2352x1568px · fundus photo · FOV: 45 degrees: 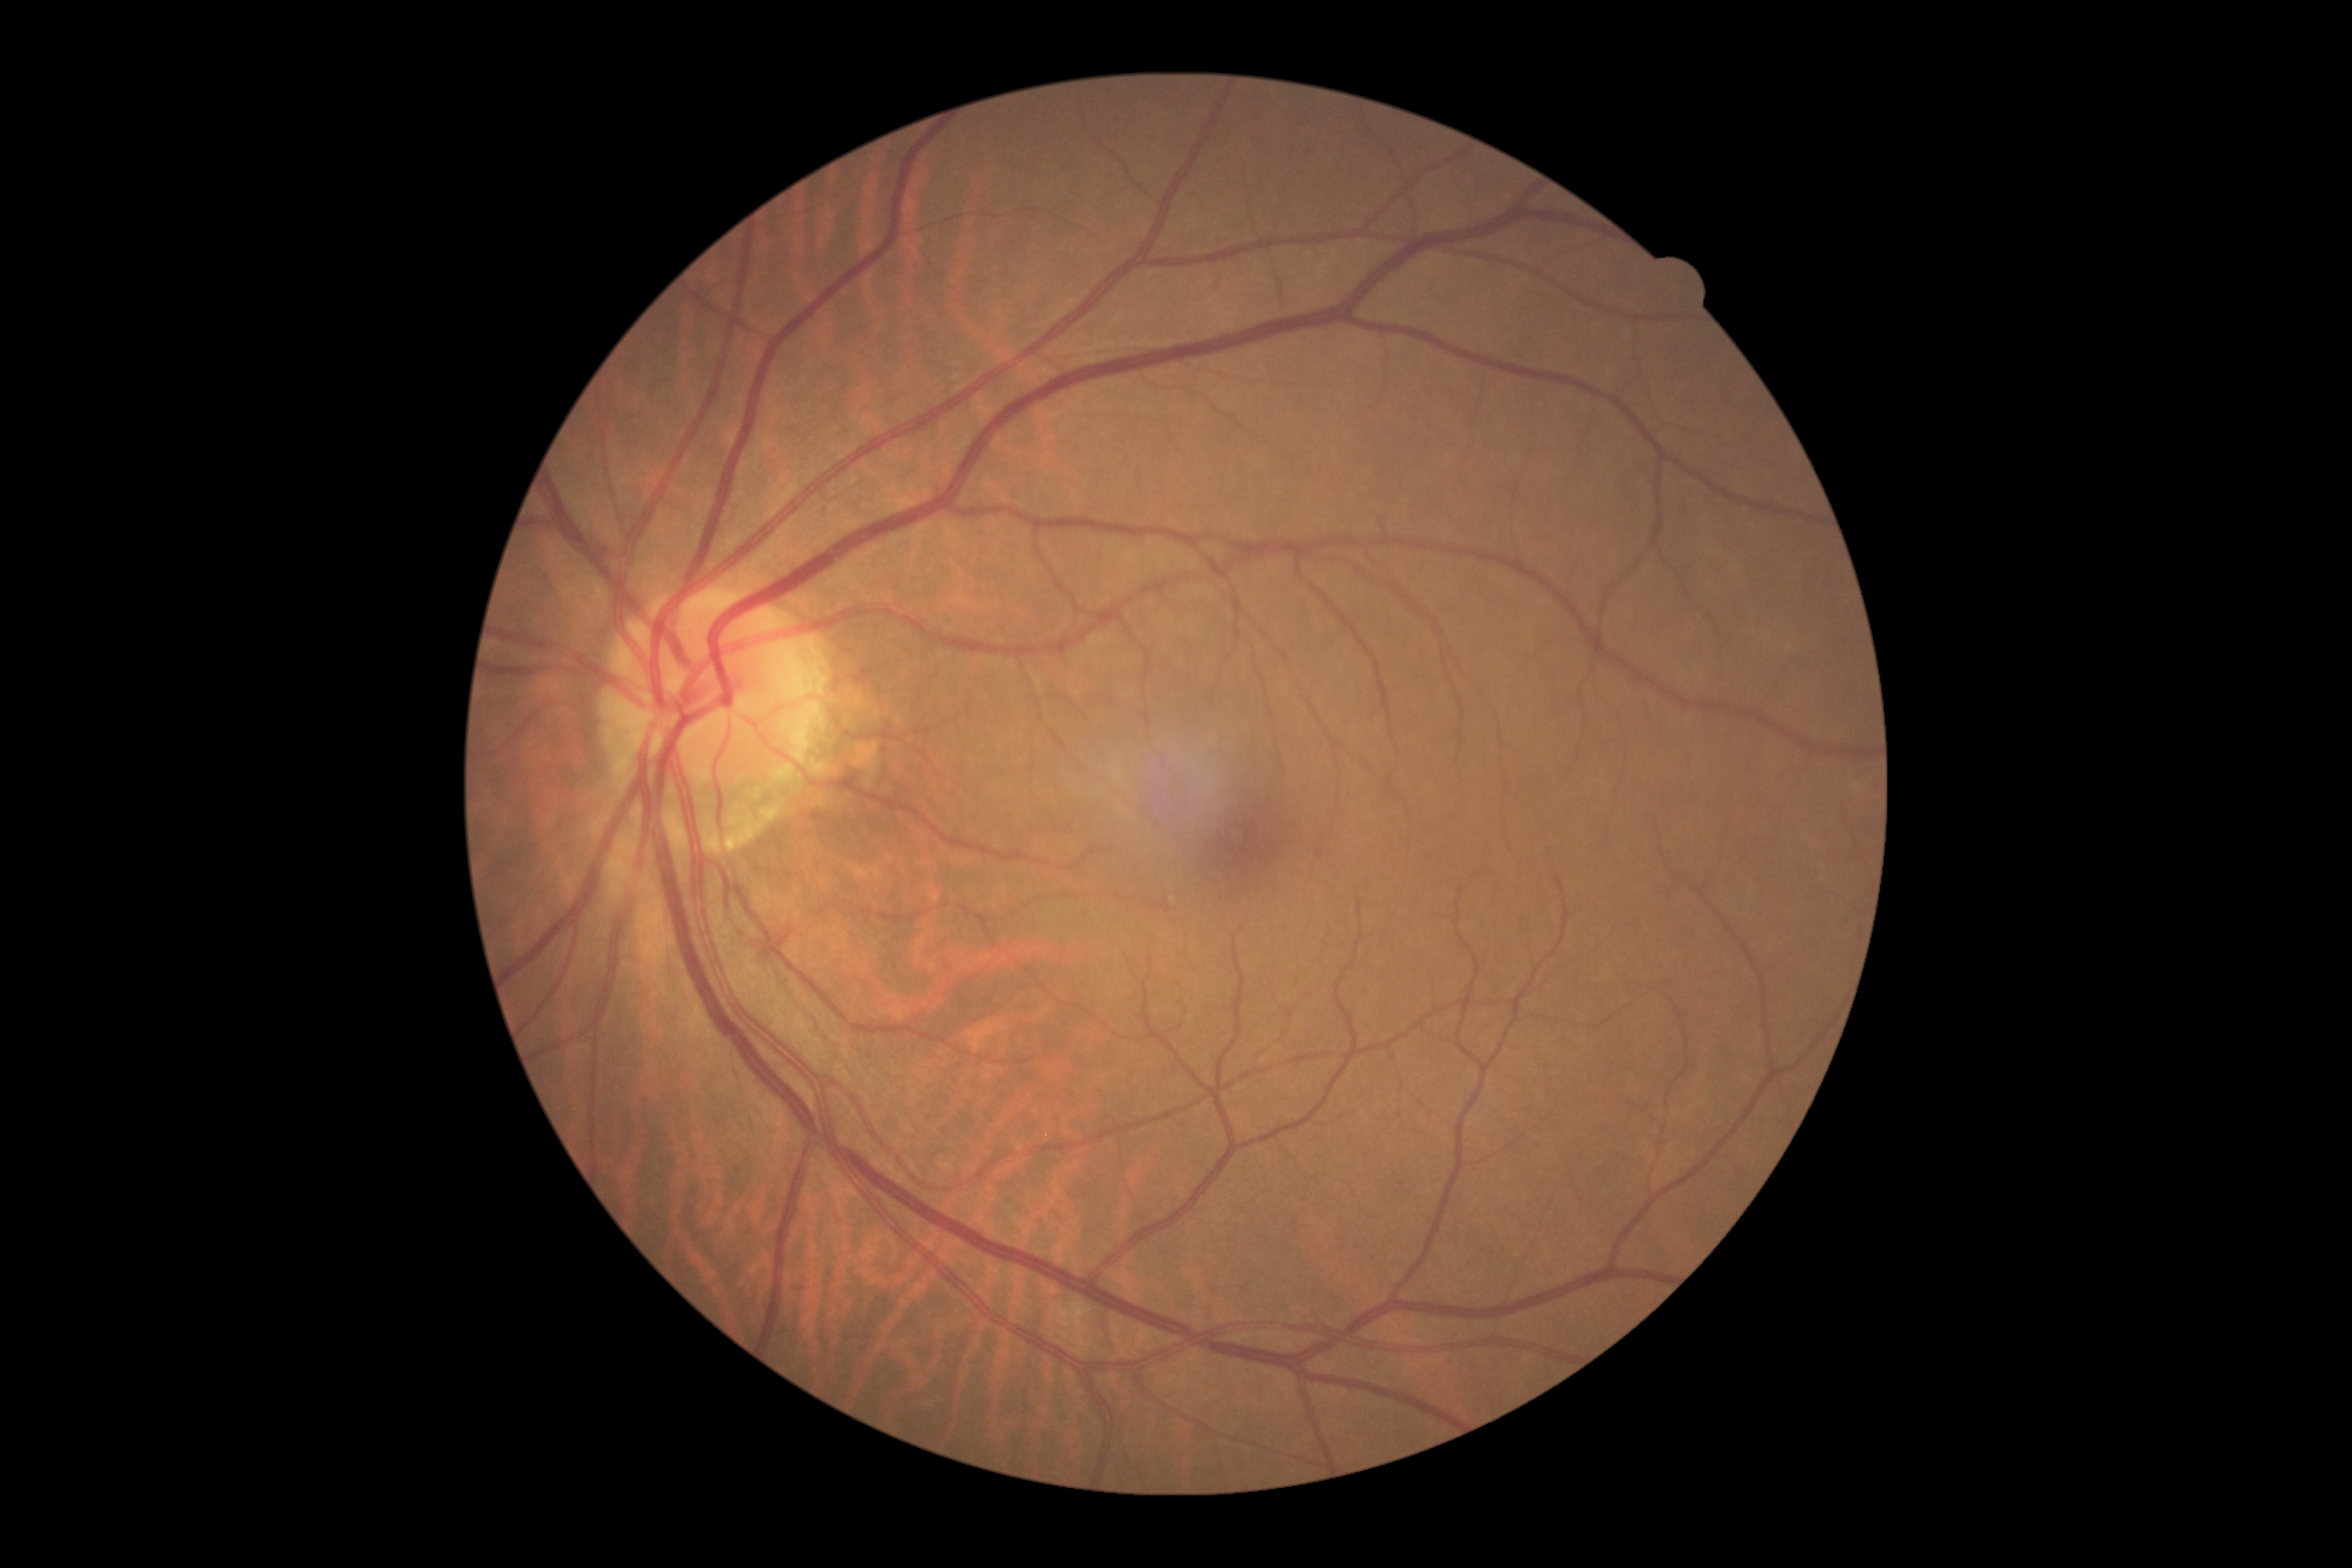 Retinopathy: 0 — no visible signs of diabetic retinopathy.
No apparent diabetic retinopathy.